130° field of view (Clarity RetCam 3); pediatric wide-field fundus photograph
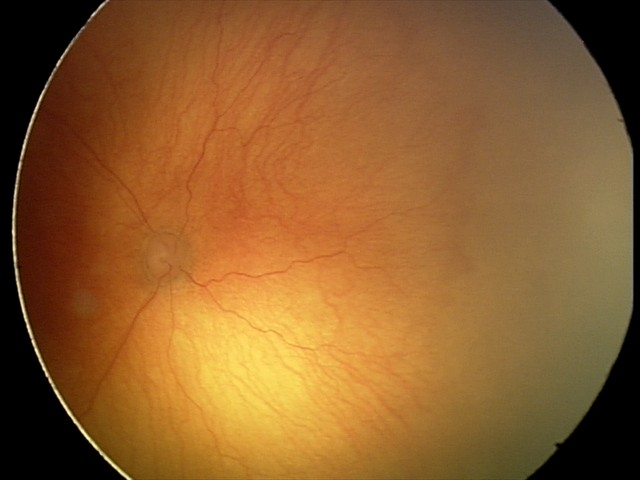 From an examination with diagnosis of aggressive retinopathy of prematurity.
Plus disease present.